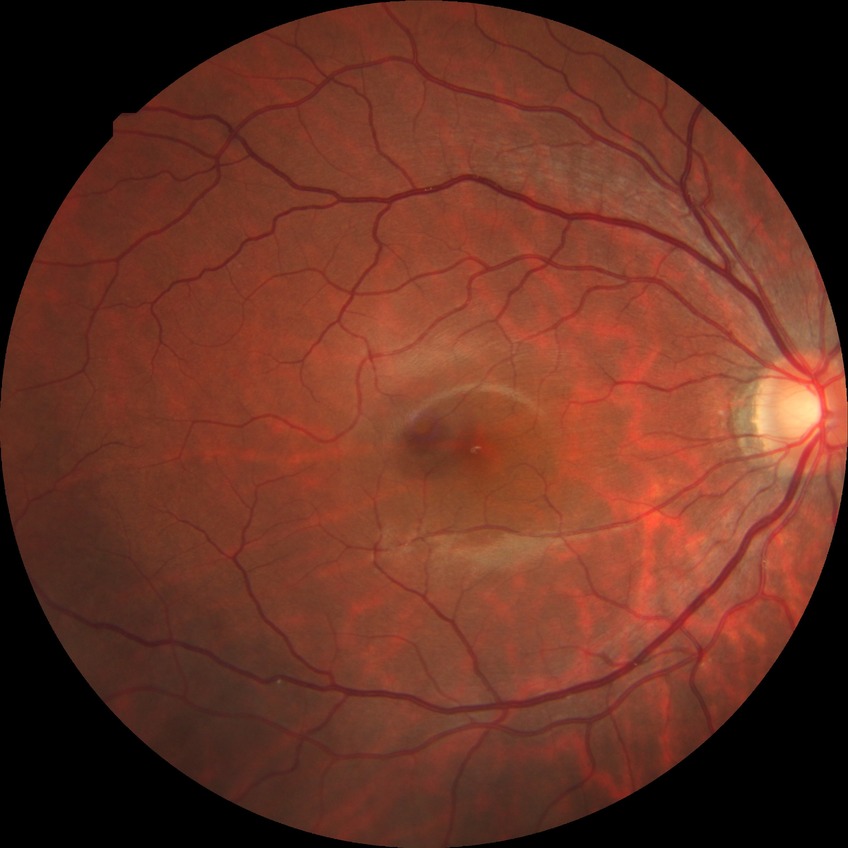
Davis grading = simple diabetic retinopathy
DR class = non-proliferative diabetic retinopathy